Pediatric wide-field fundus photograph. 640x480 — 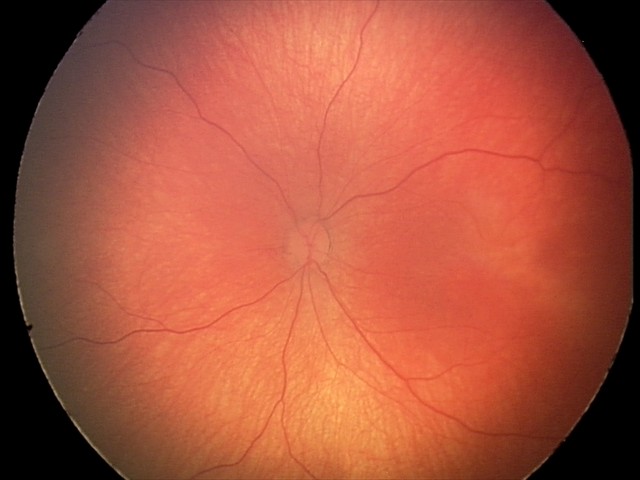 Diagnosis from this screening exam: retinal hemorrhages.